Axial length: 25.39 mm: 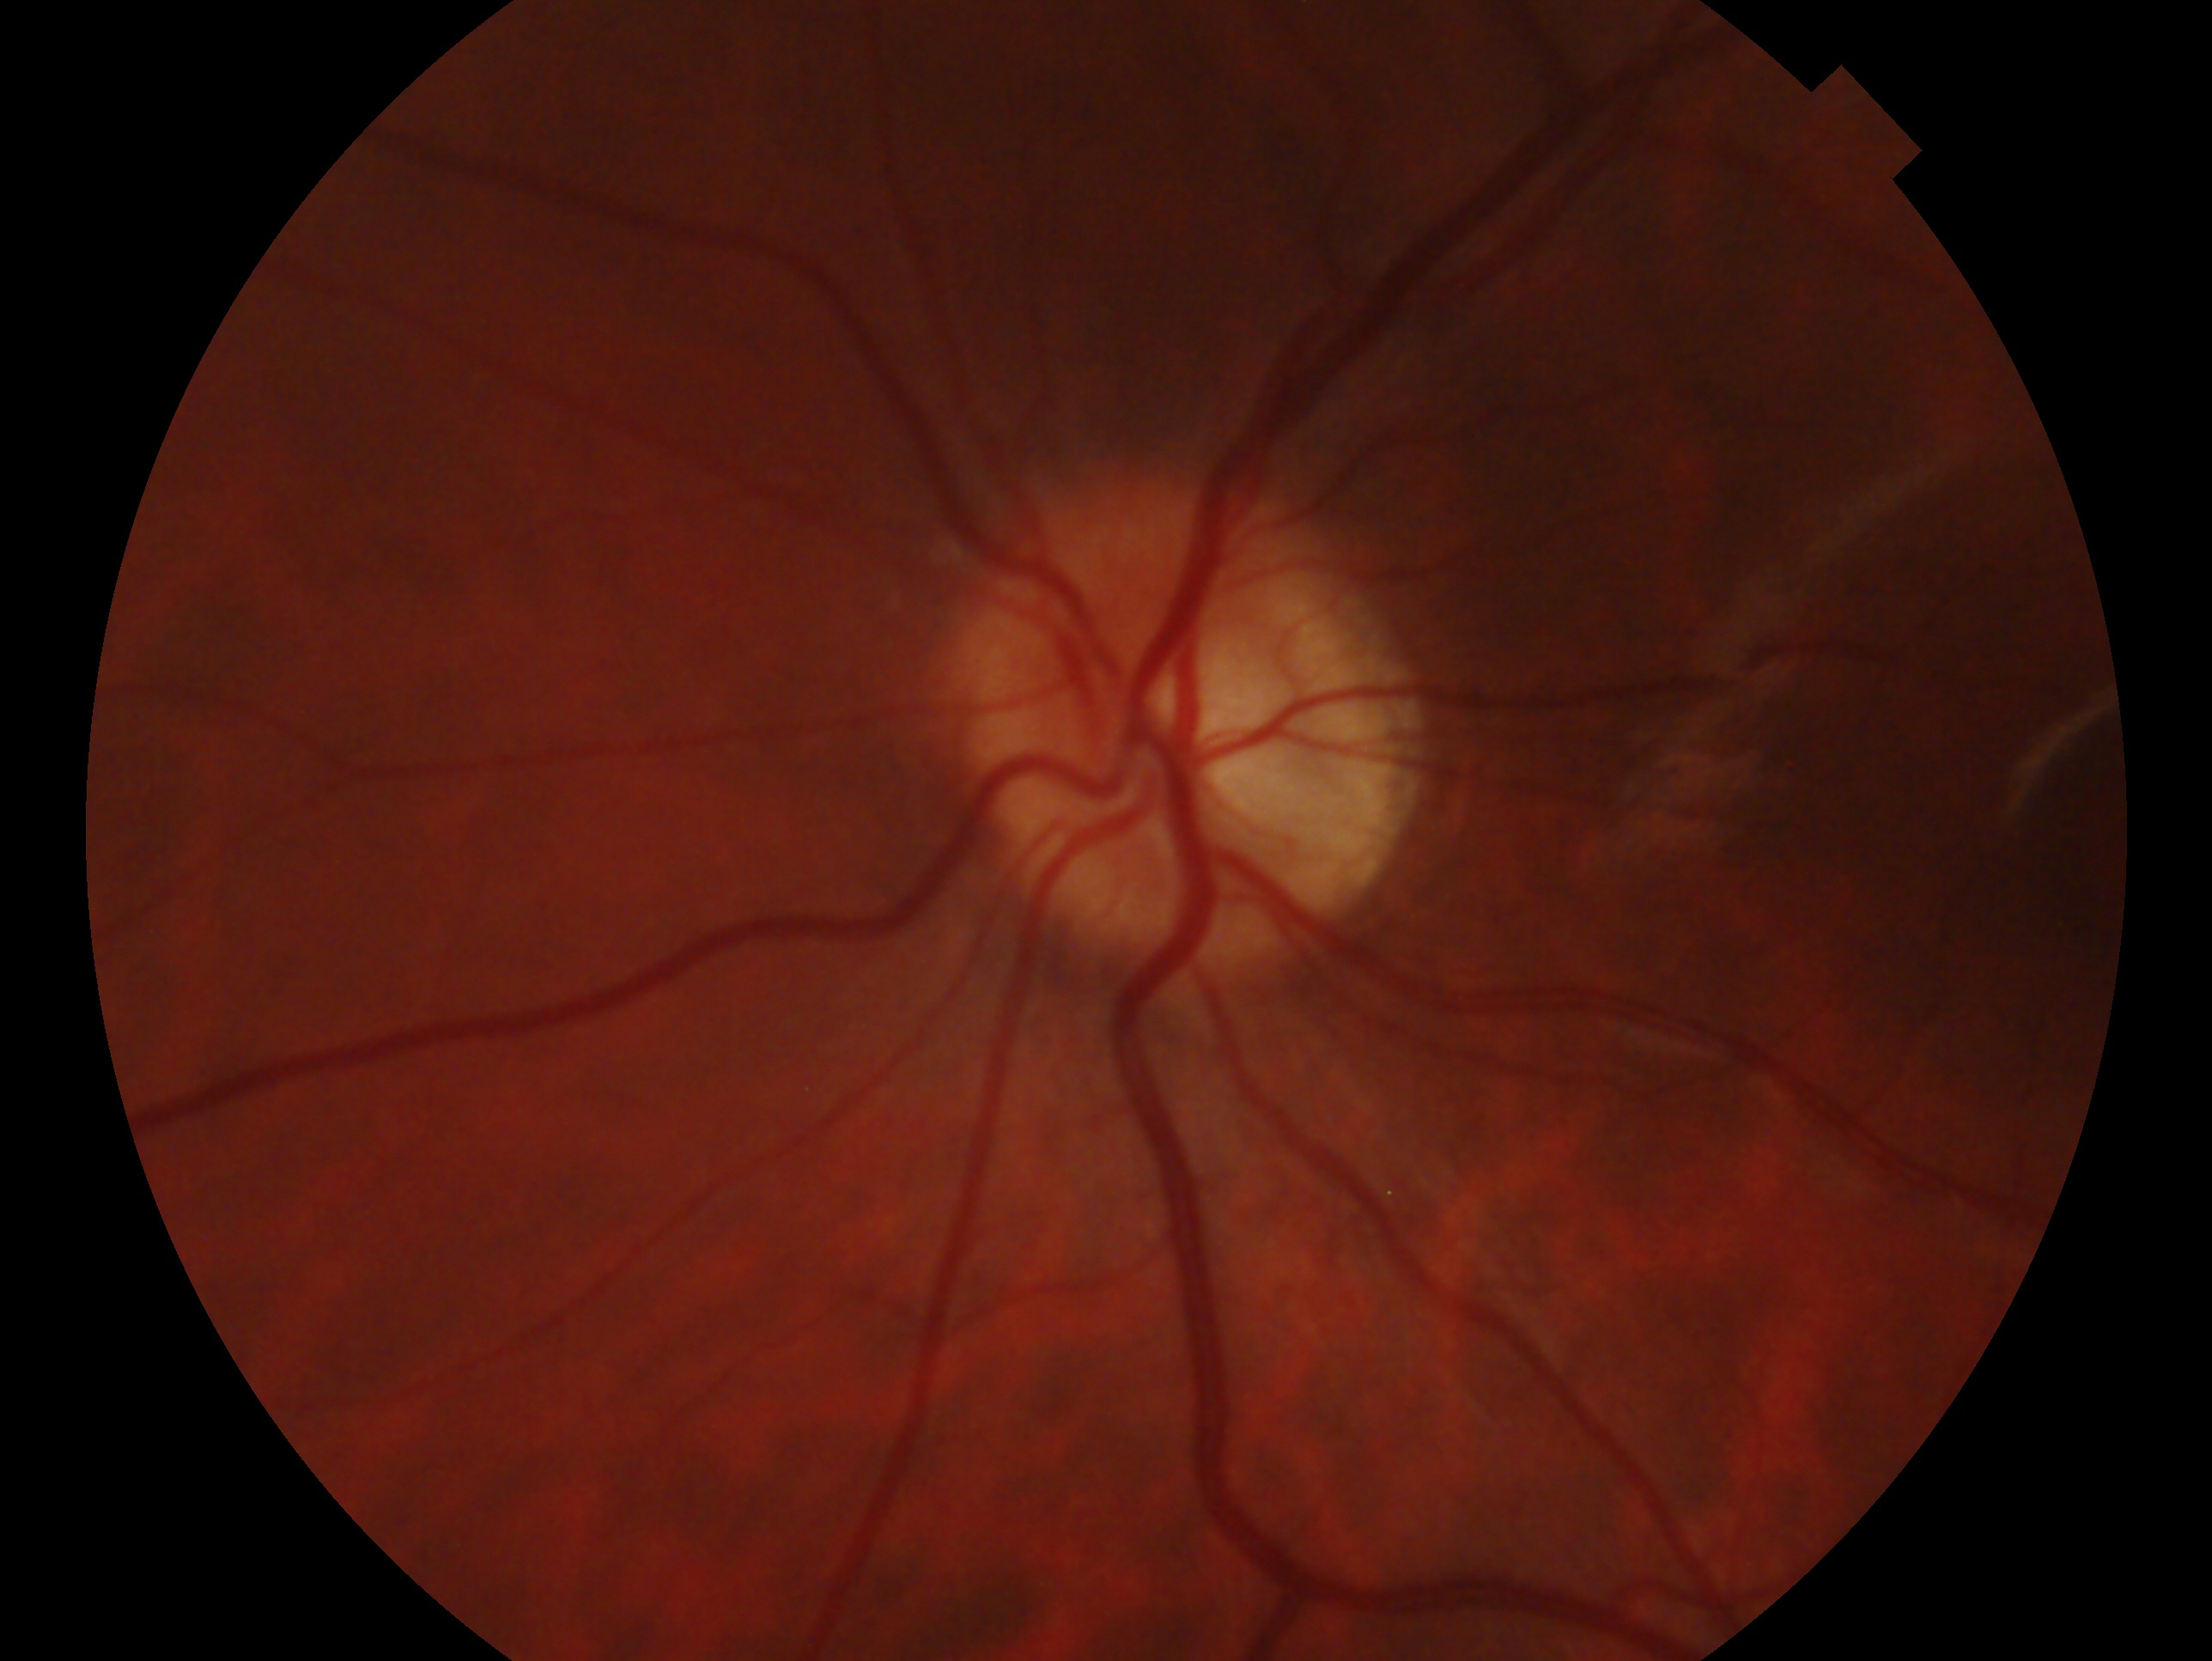
Eye: left.
Impression — no glaucomatous findings.